Captured with the Phoenix ICON (100° field of view); image size 1240x1240; wide-field fundus photograph of an infant: 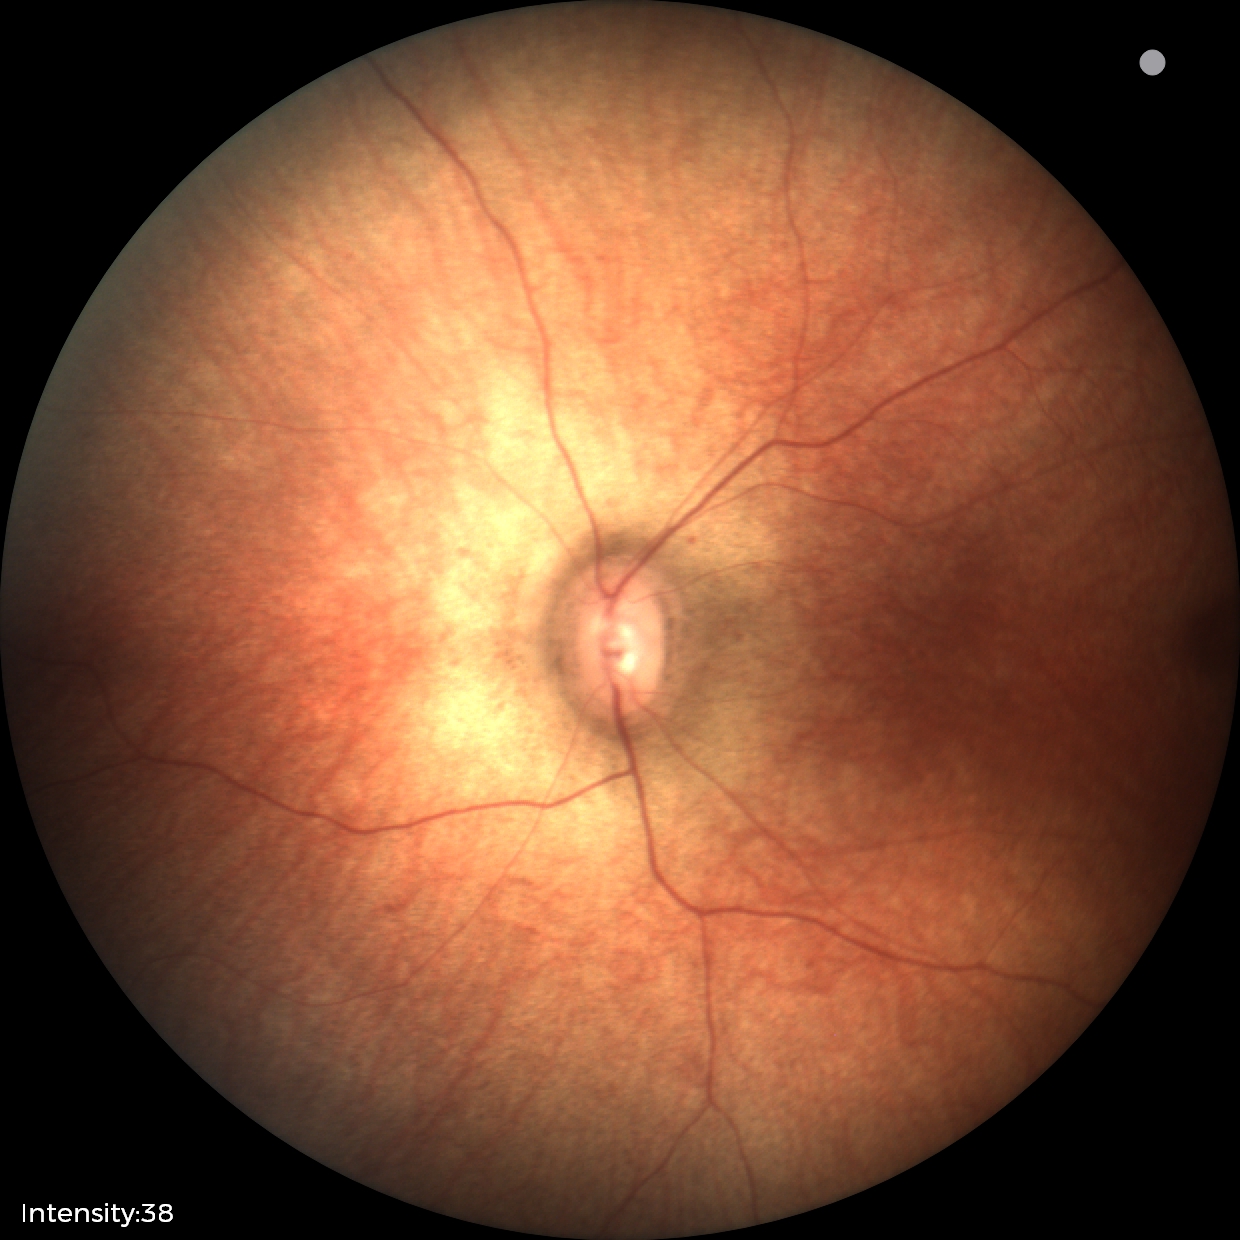 Diagnosis = no abnormalities